2212 x 1659 pixels: 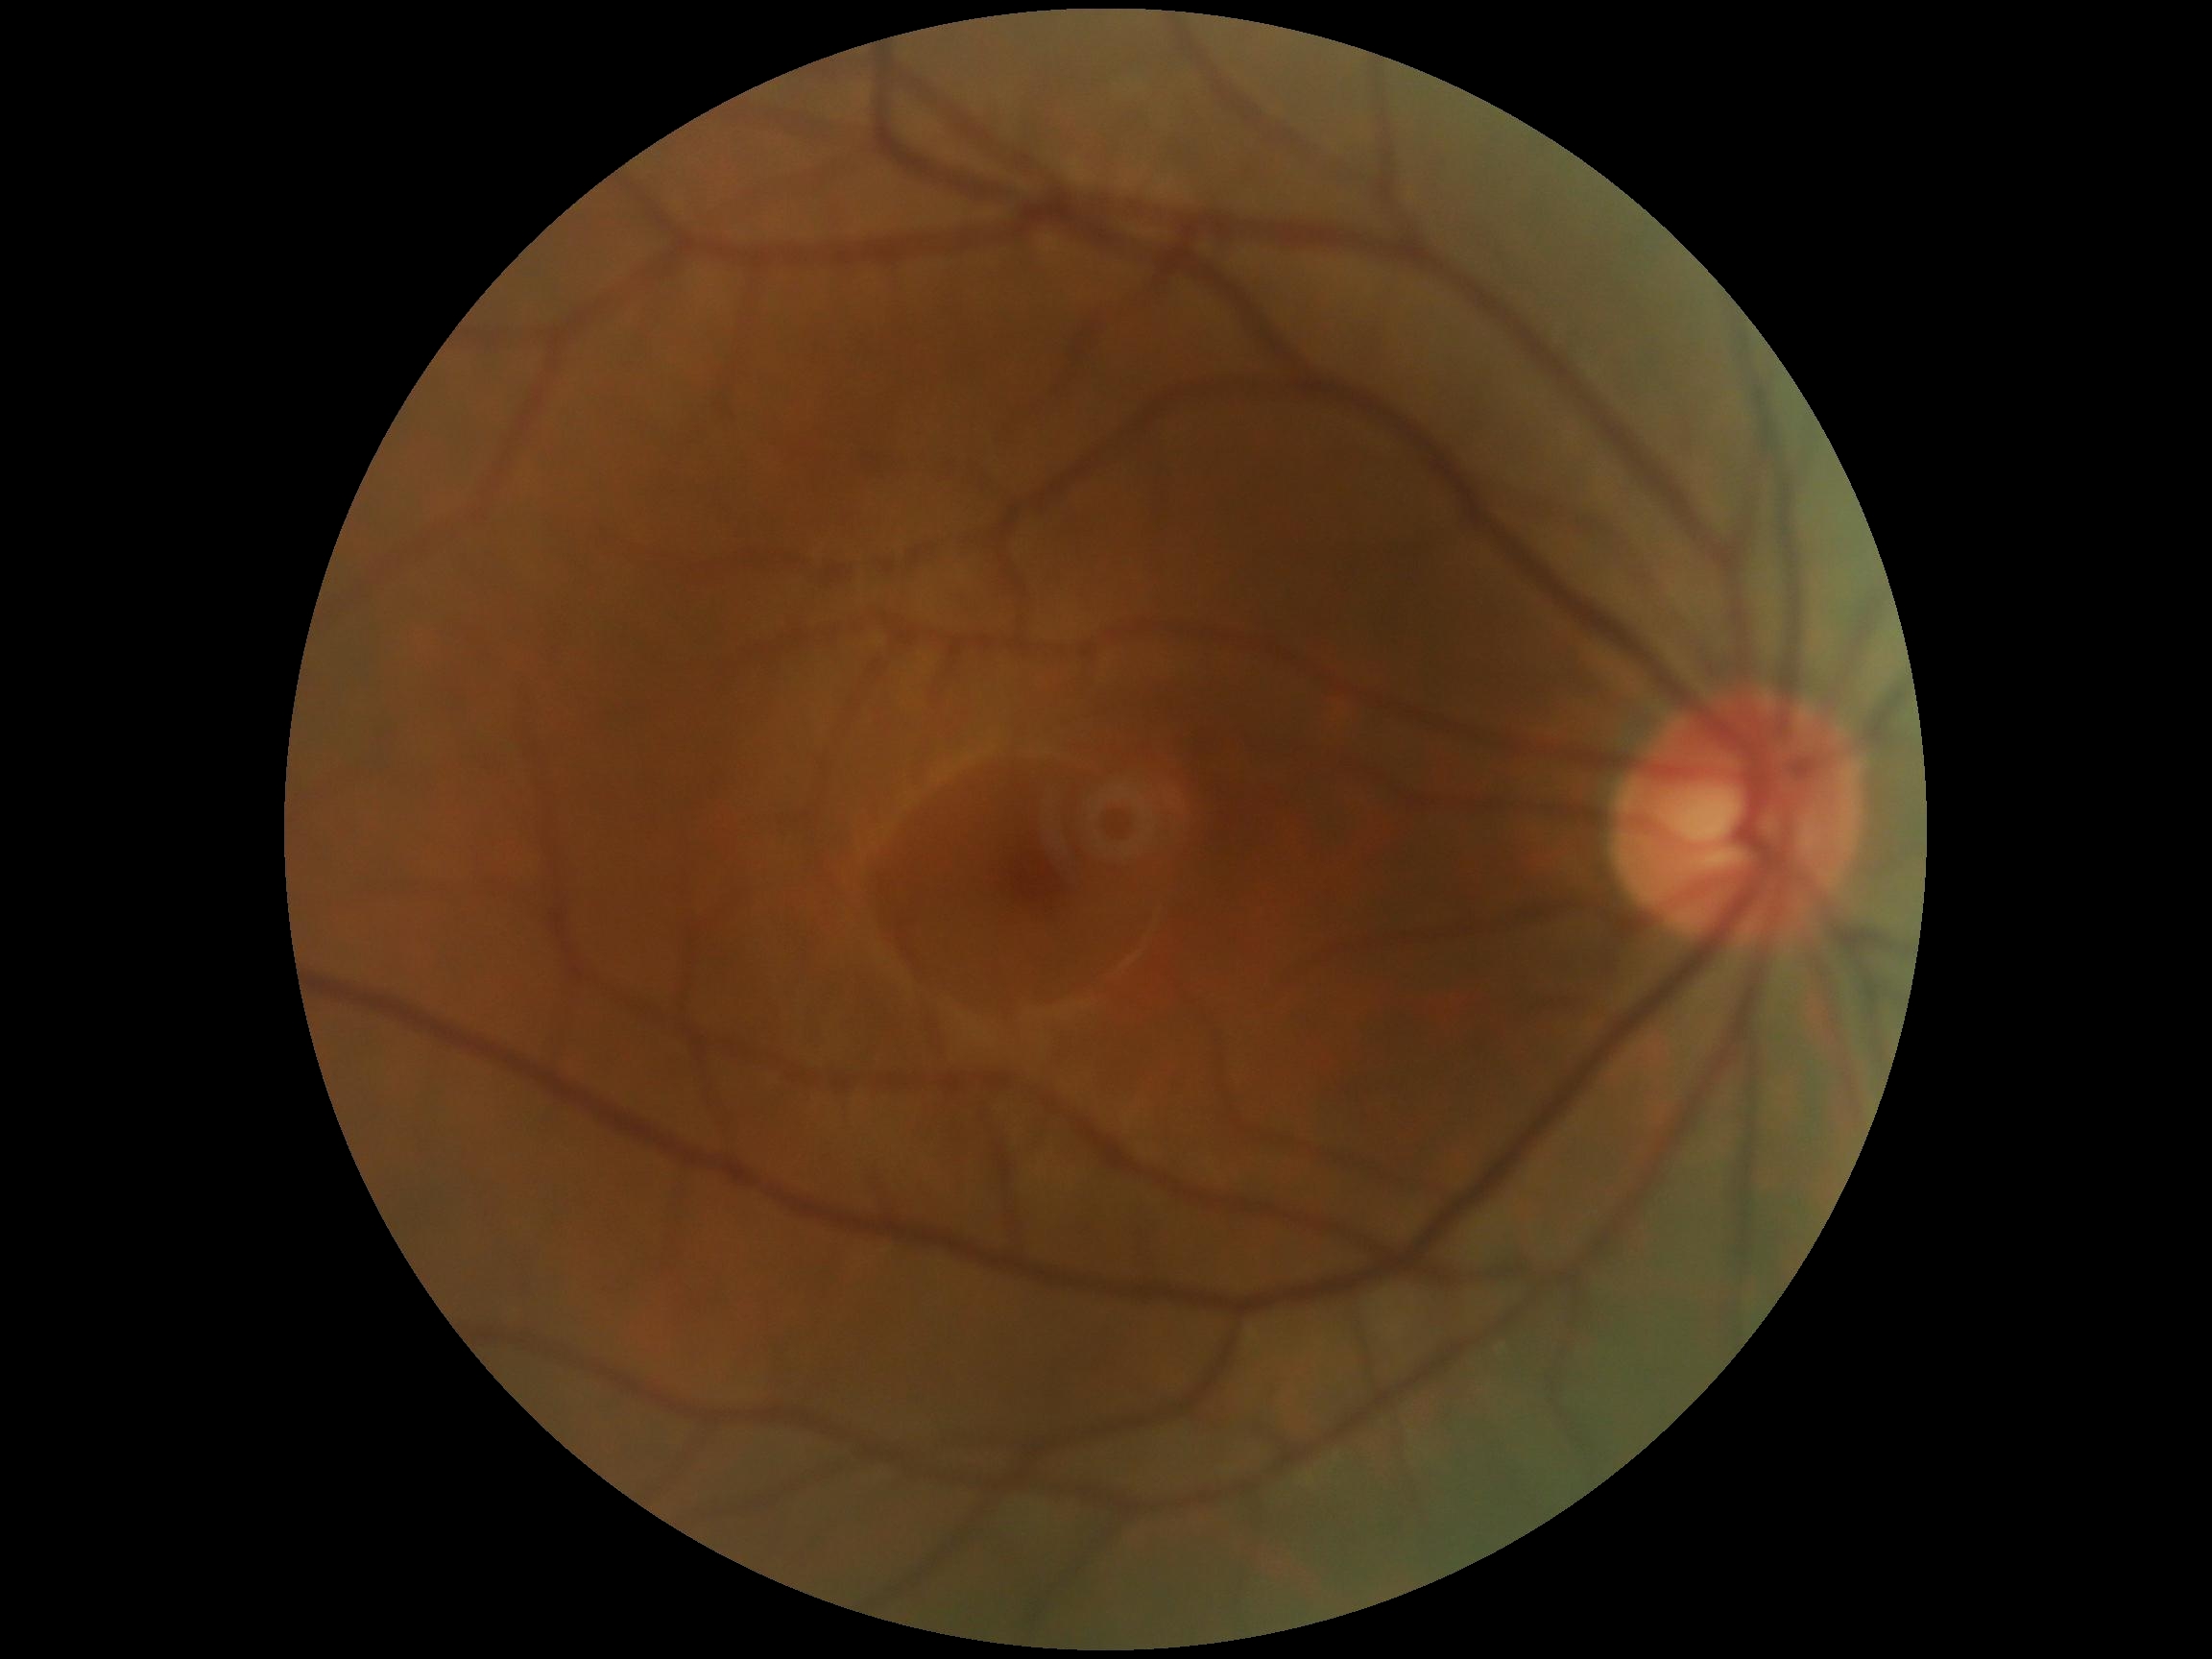
  dr_grade: 0